FOV: 45 degrees, retinal fundus photograph, 2352x1568 — 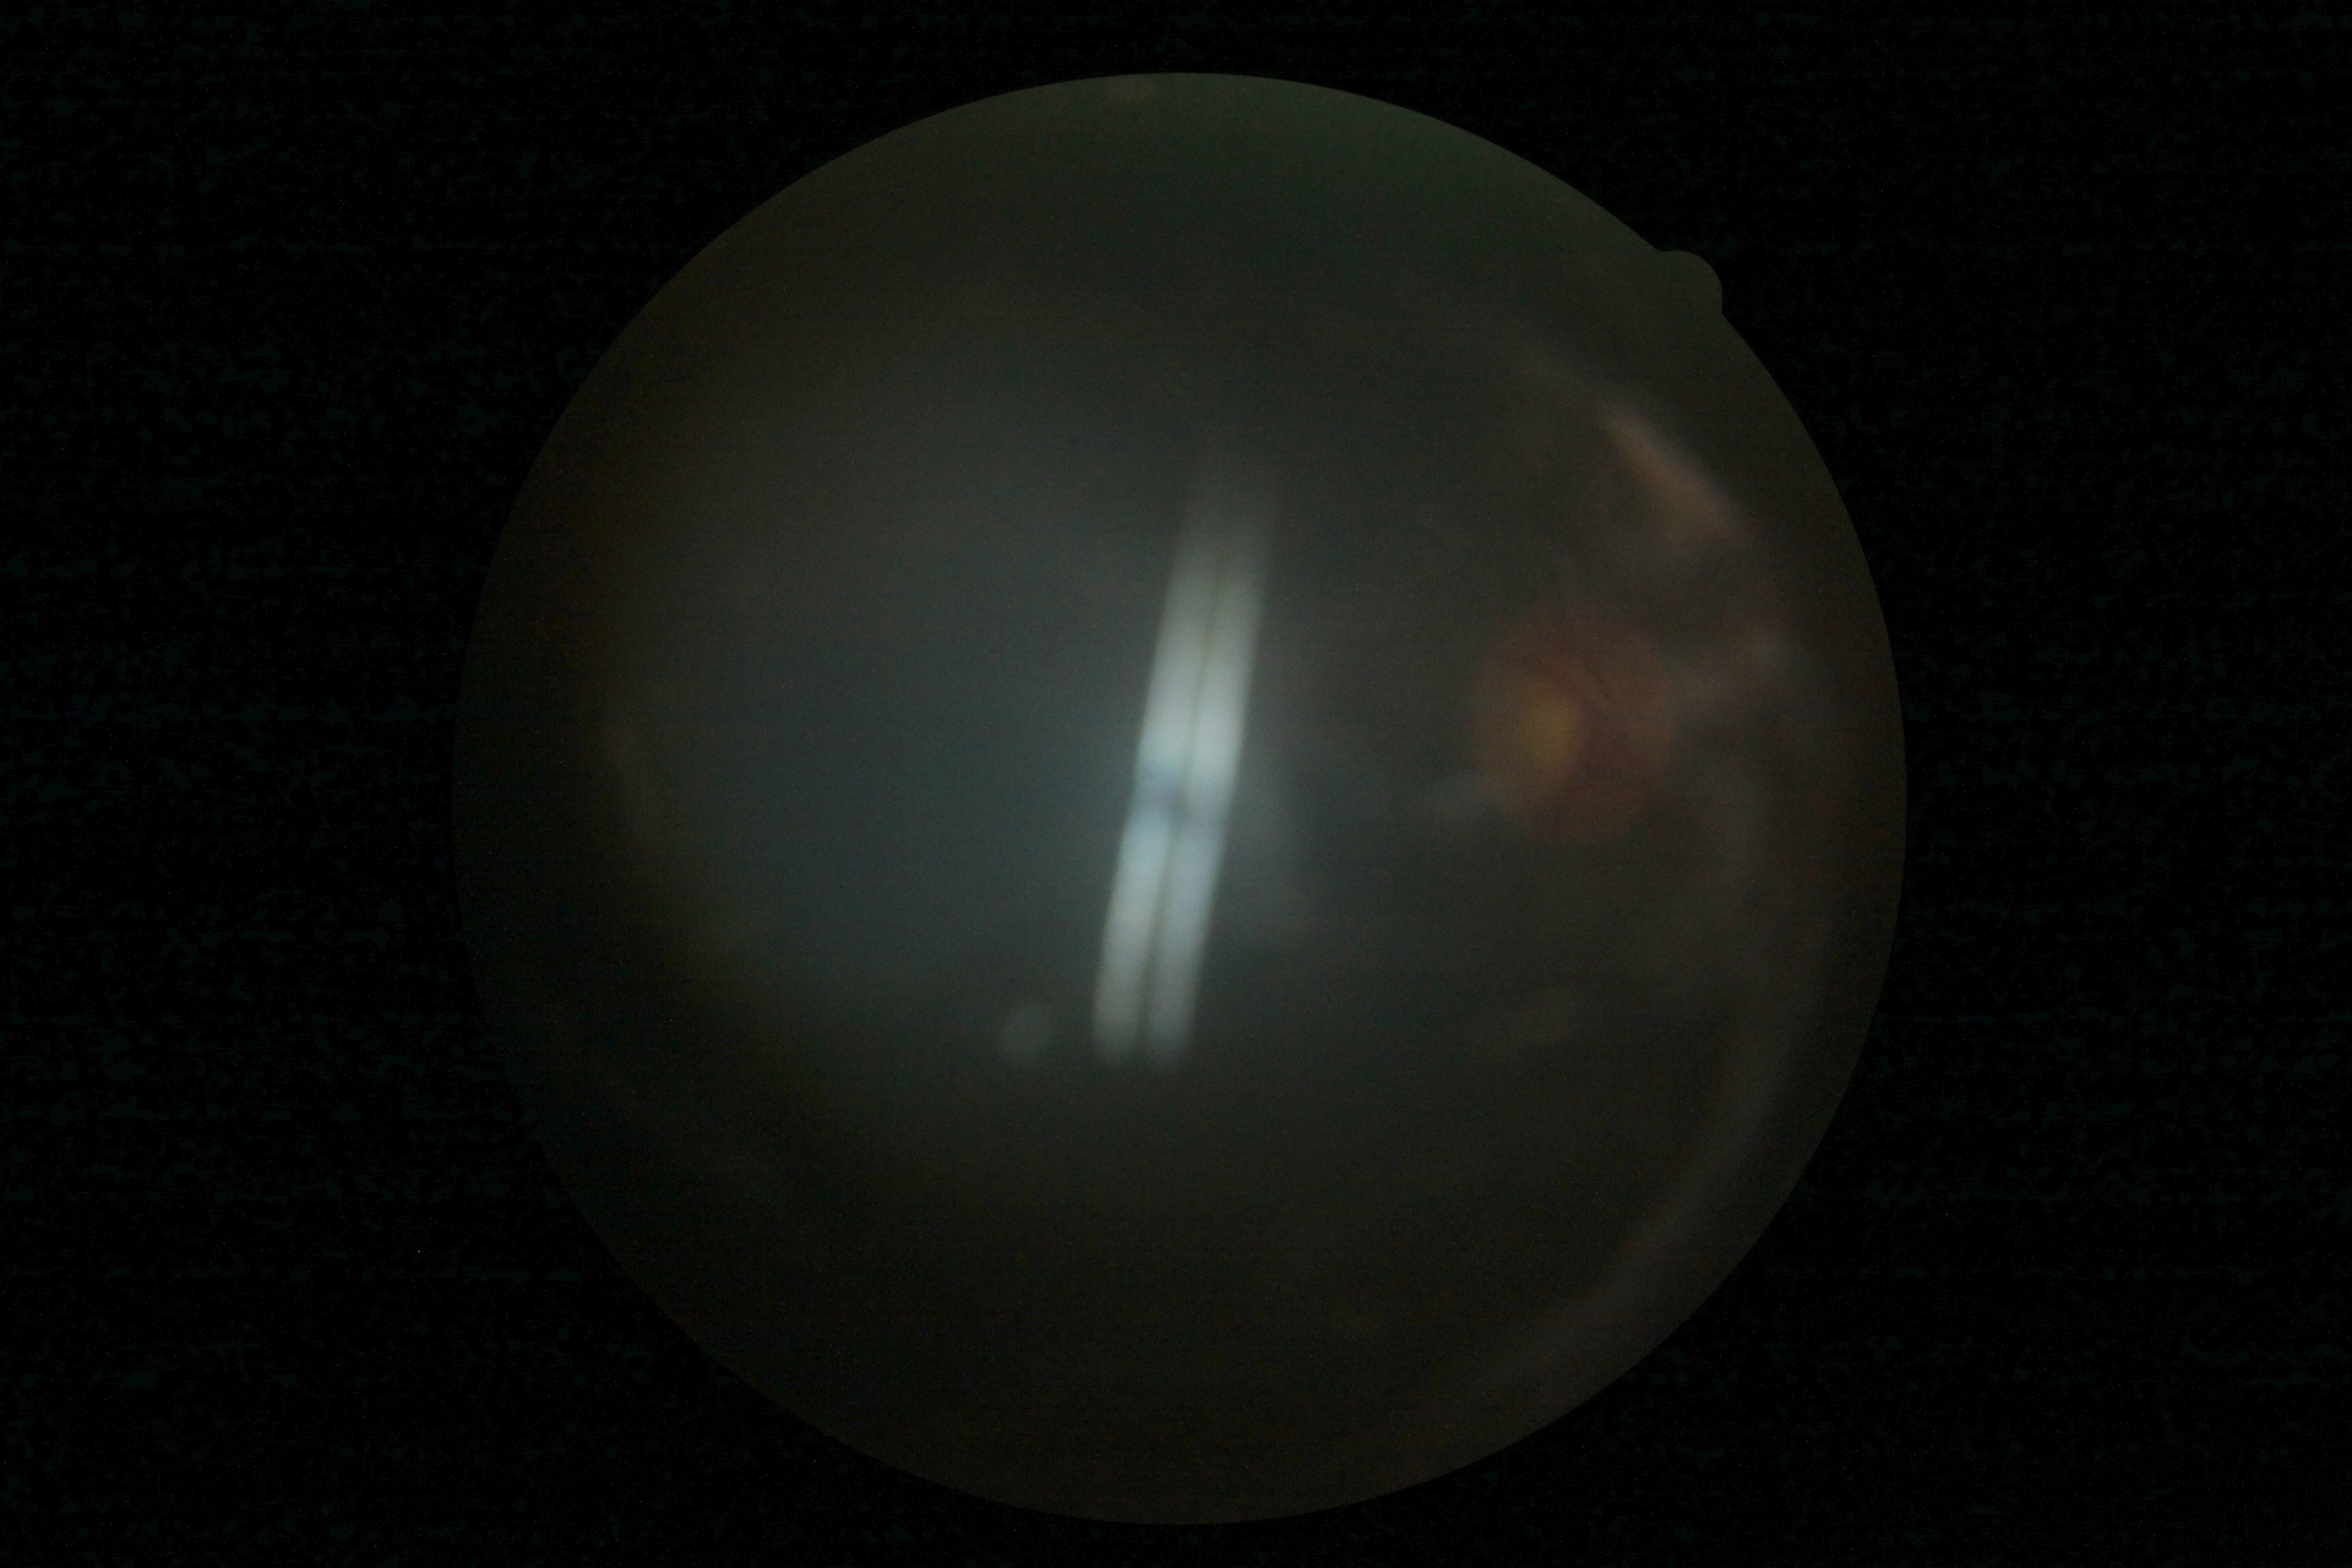

Diabetic retinopathy: ungradable.
The image cannot be graded for diabetic retinopathy.